Graded on the modified Davis scale — 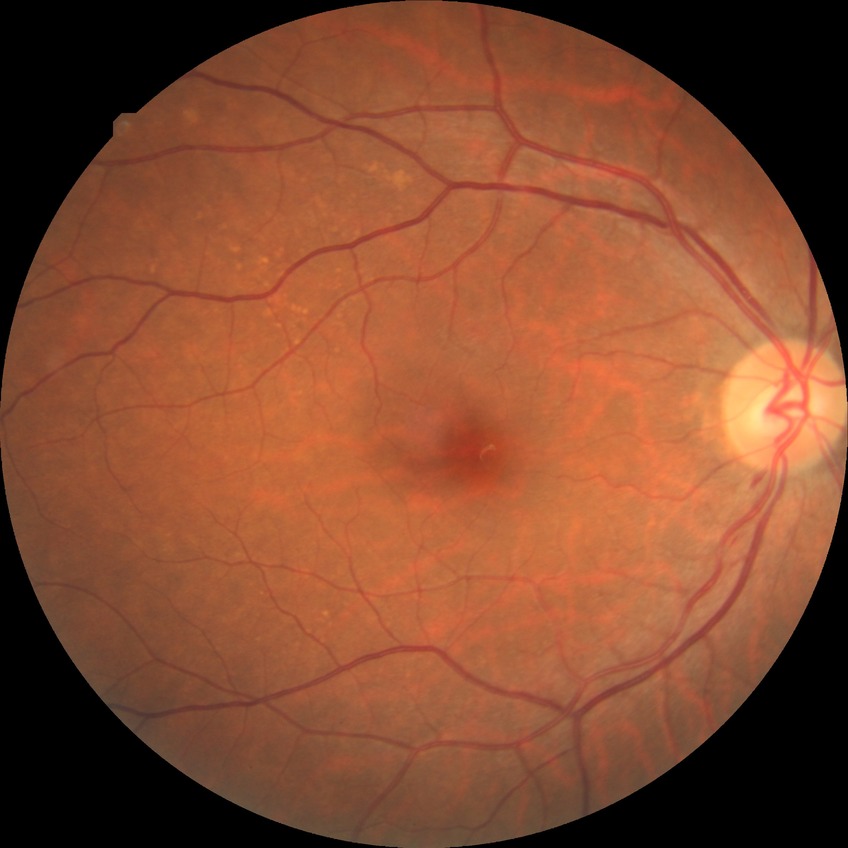 Davis grading is simple diabetic retinopathy.